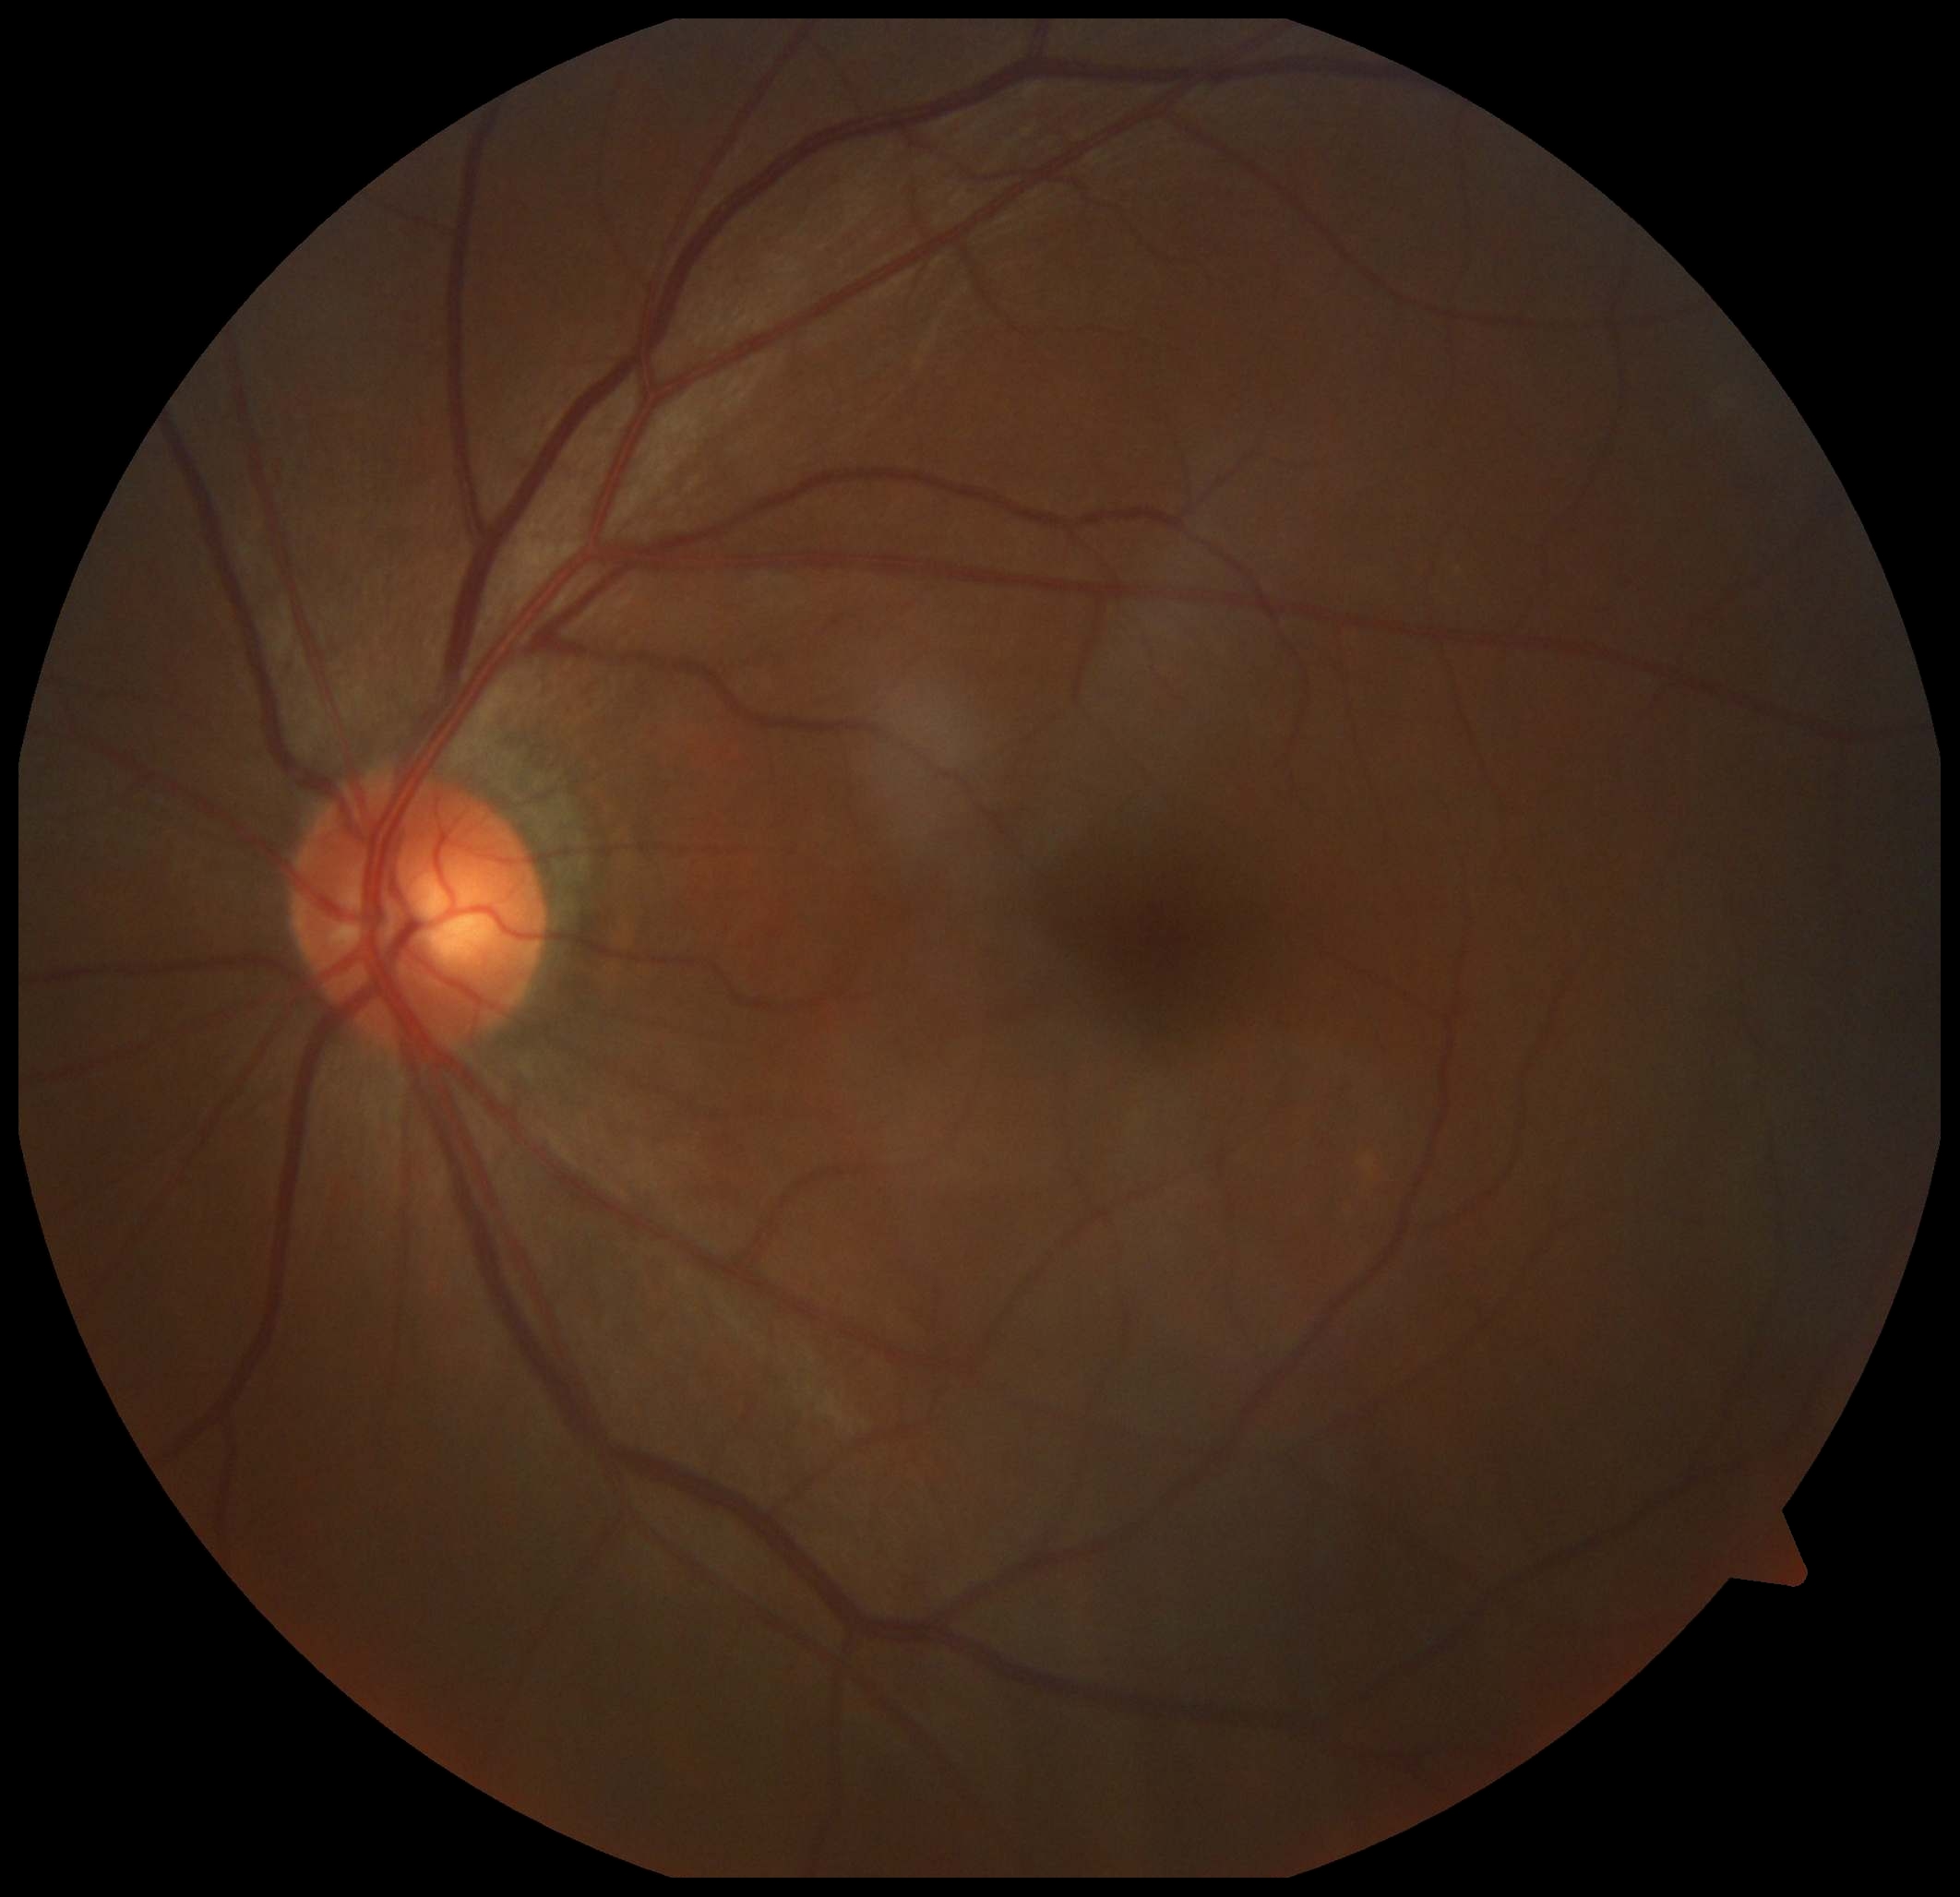
dr_grade: 0/4
dr_impression: negative for DR